Retinal fundus photograph
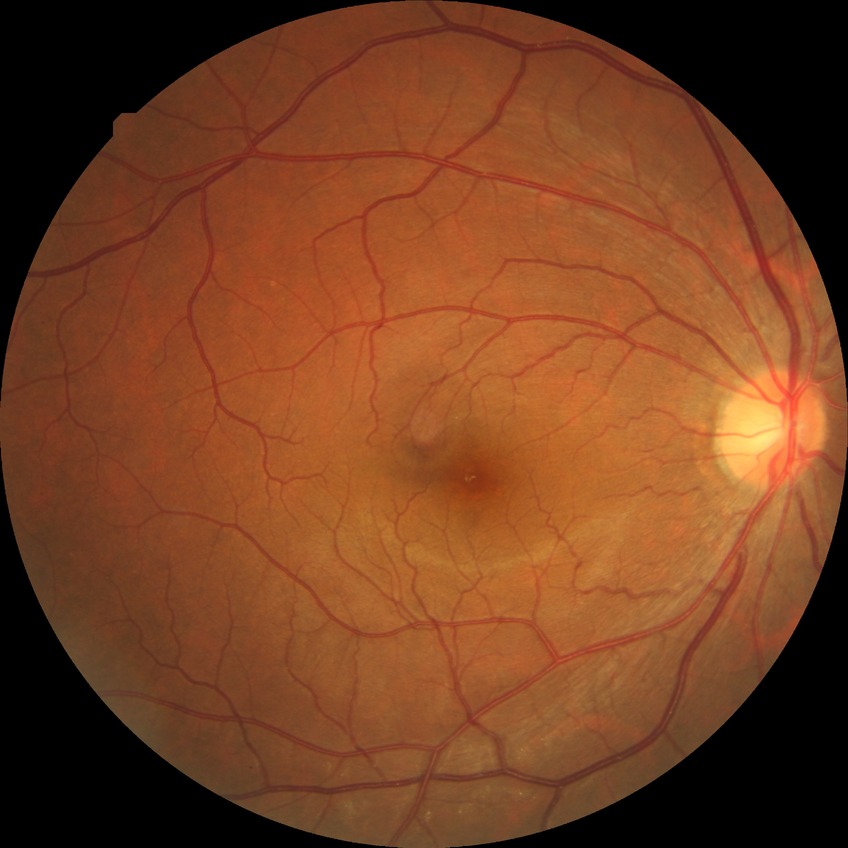 Retinopathy grade: no diabetic retinopathy.